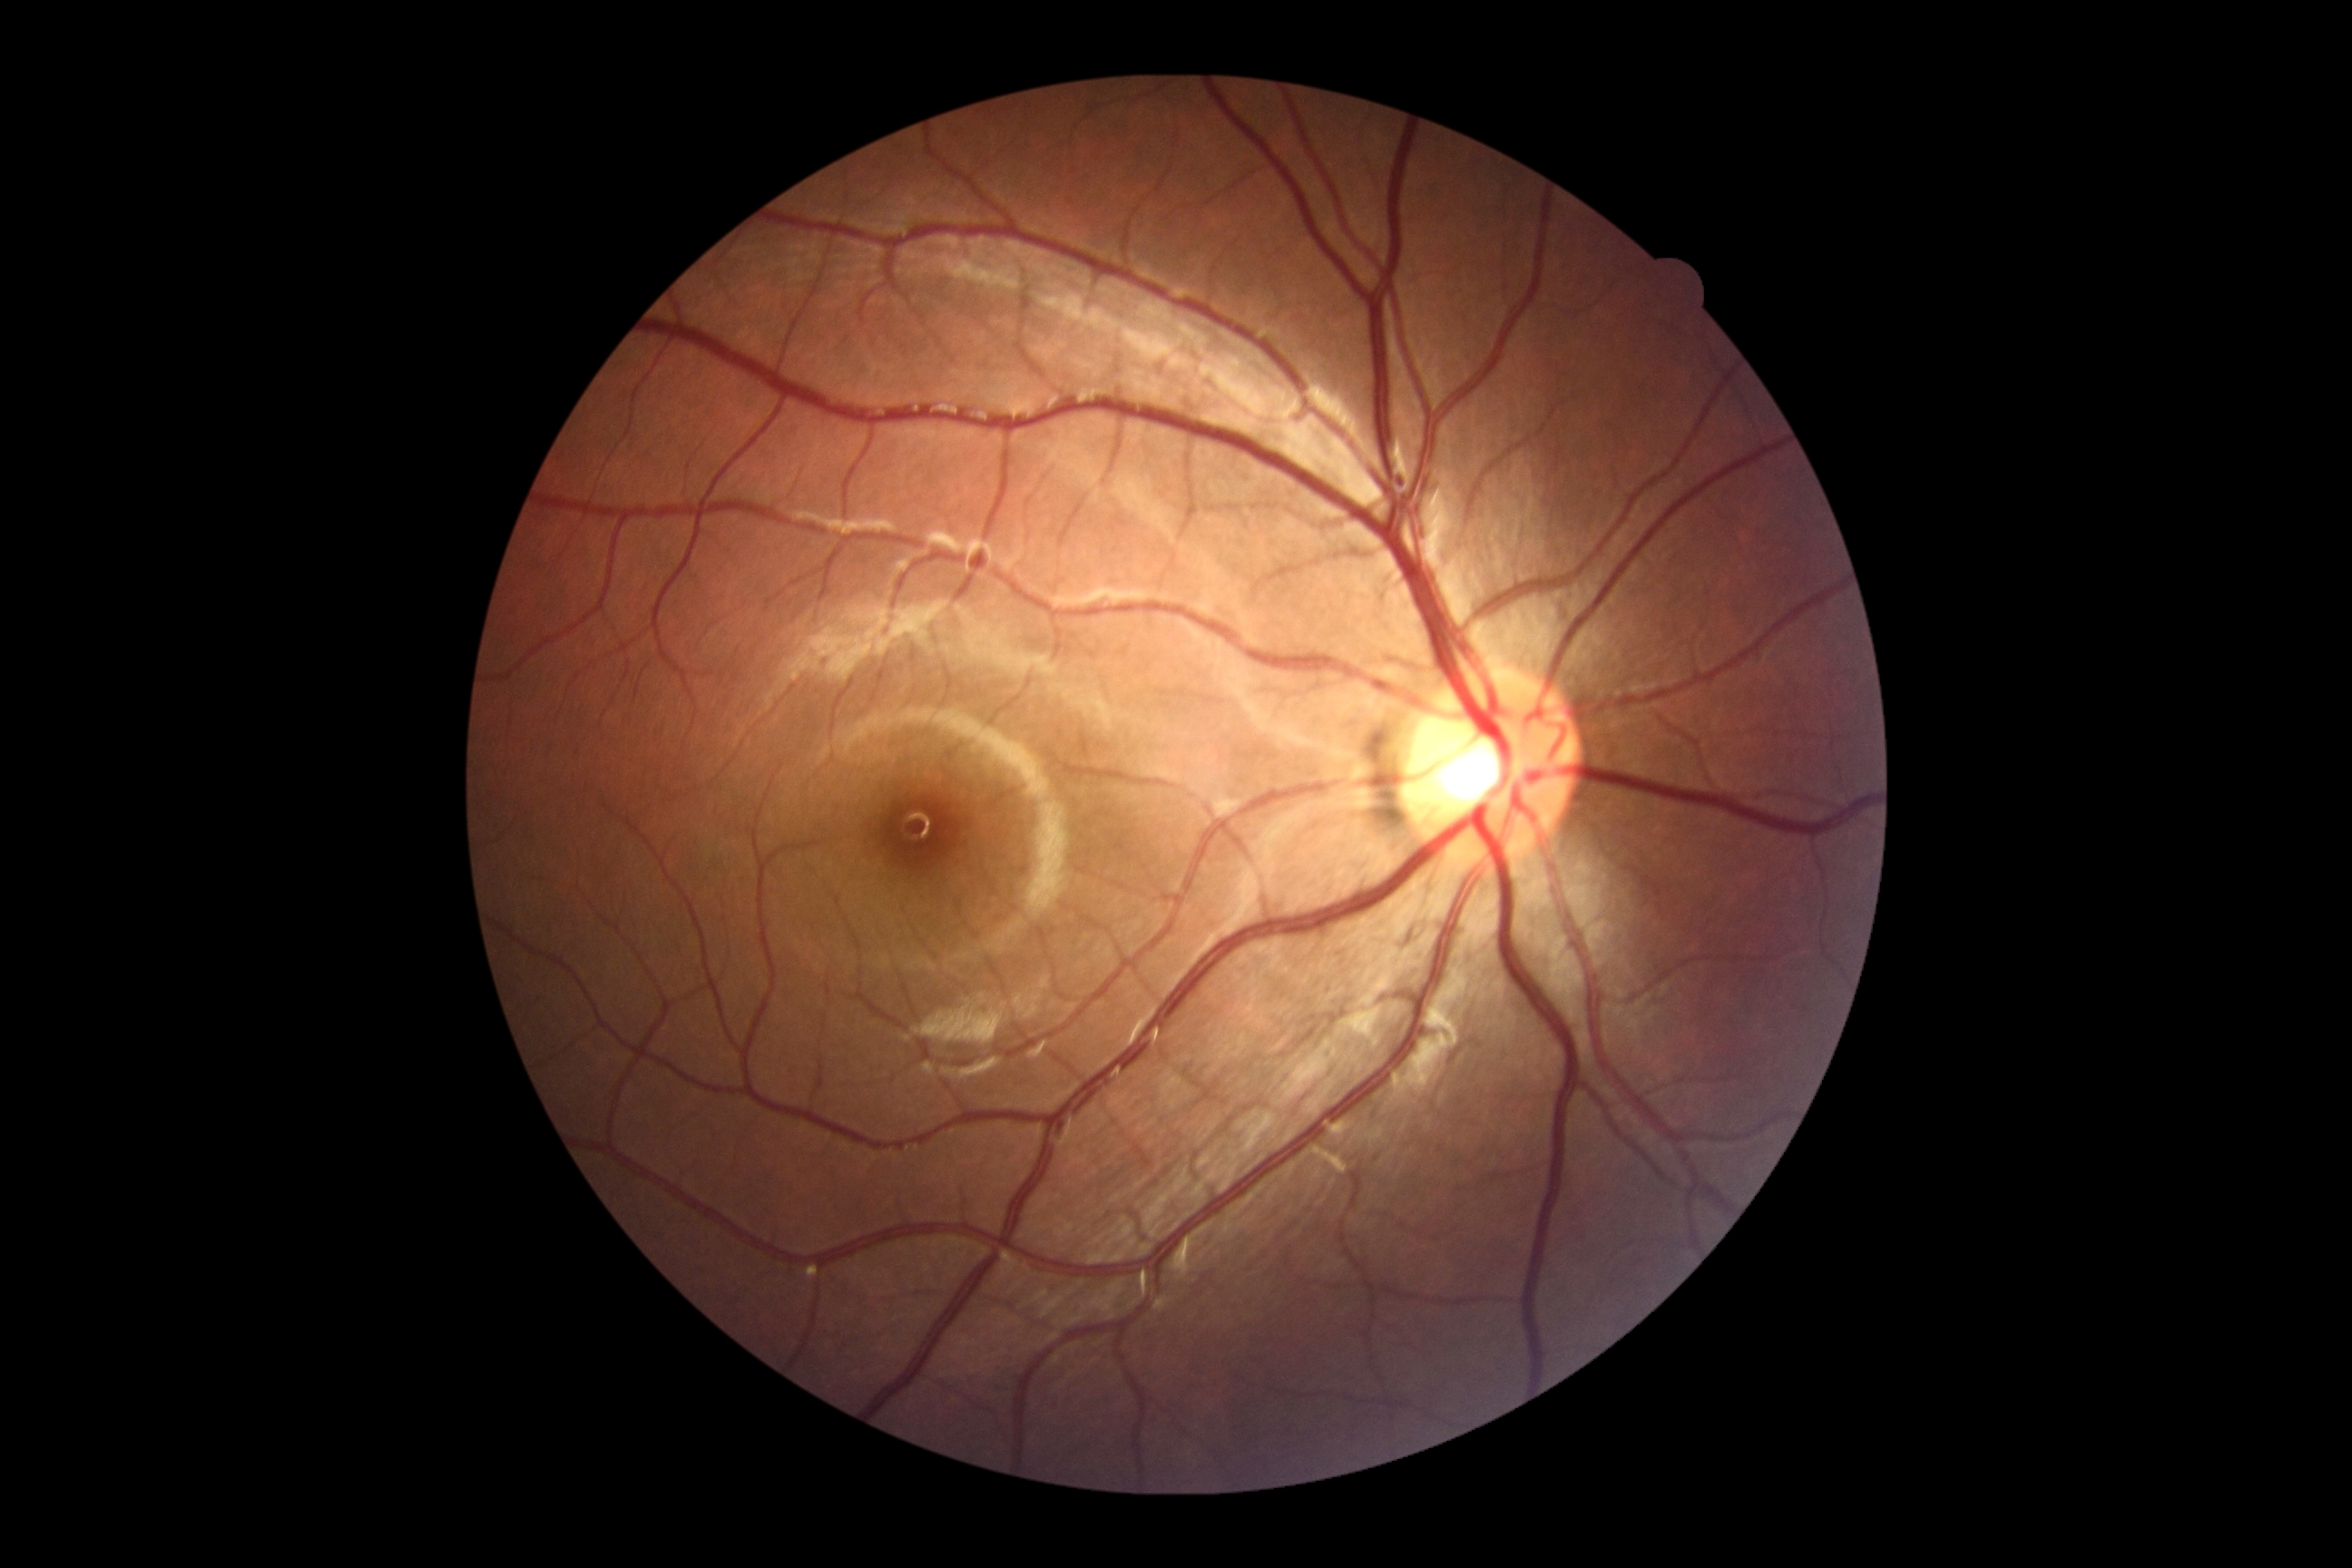
{
  "dr_grade": "0"
}